Image size 2102x1736: 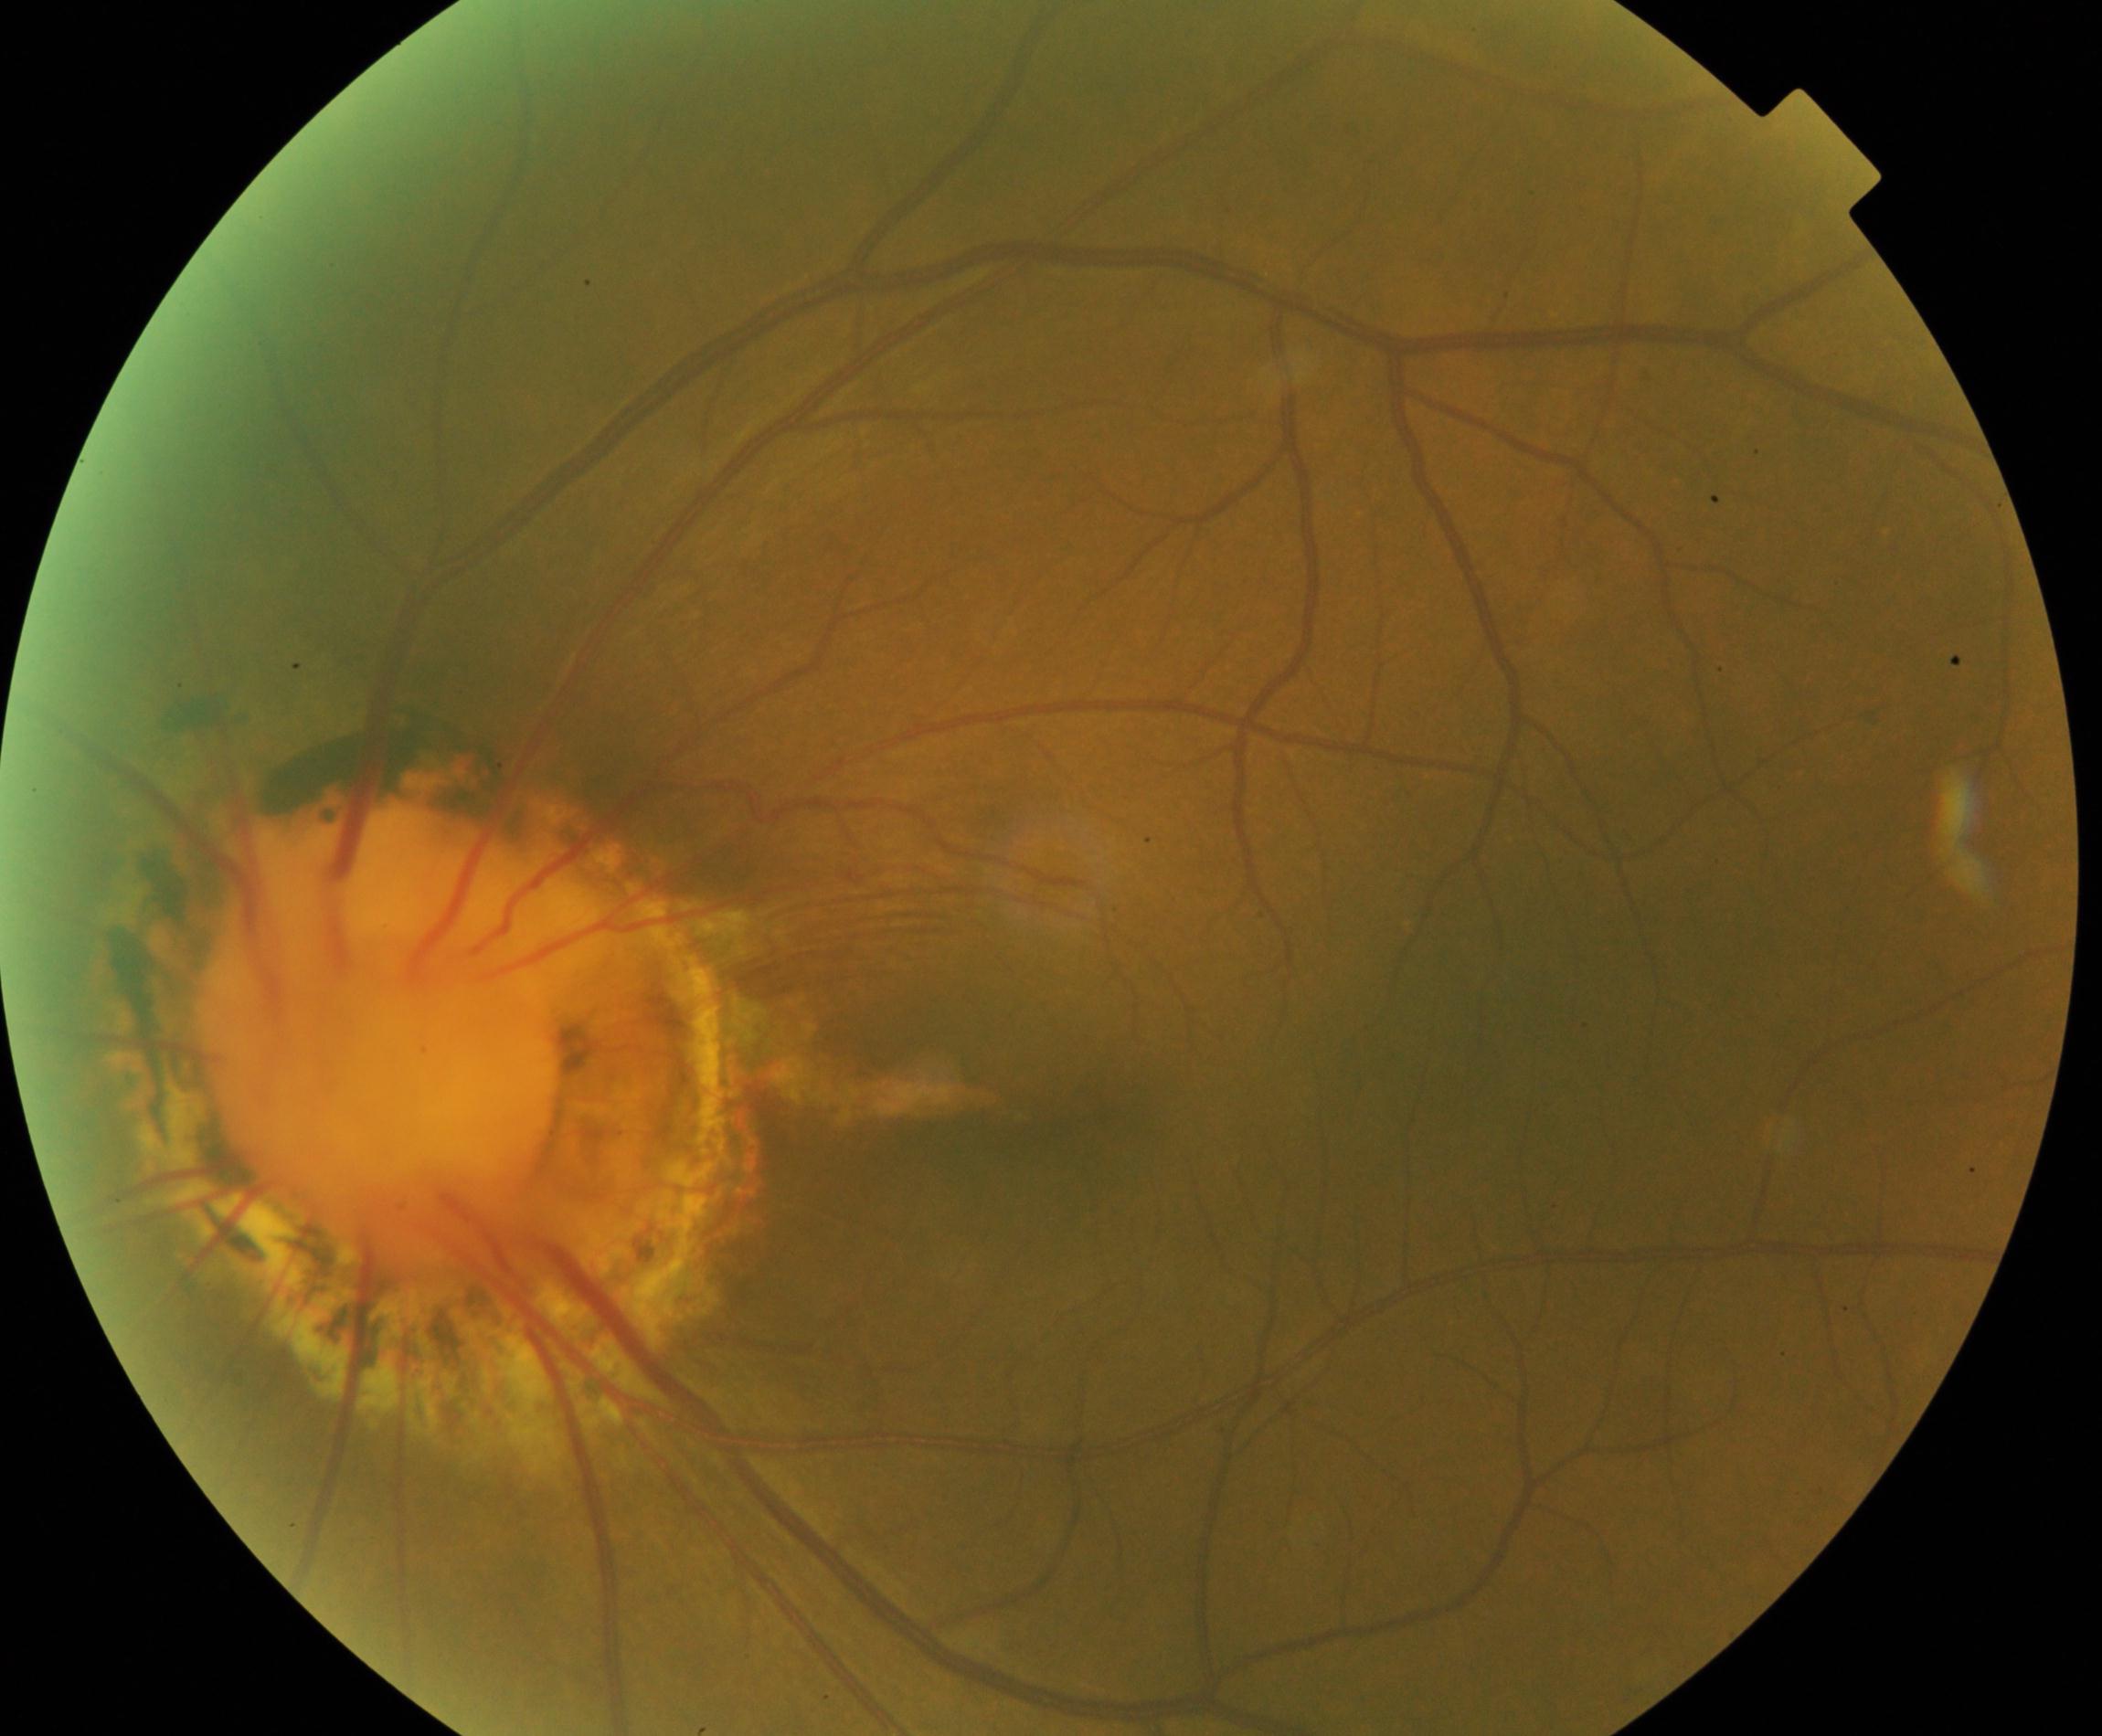 Appearance consistent with congenital disc abnormality. Characterized by optic disc coloboma, morning glory anomaly, optic pit, megalopapilla, or hypoplastic disc.